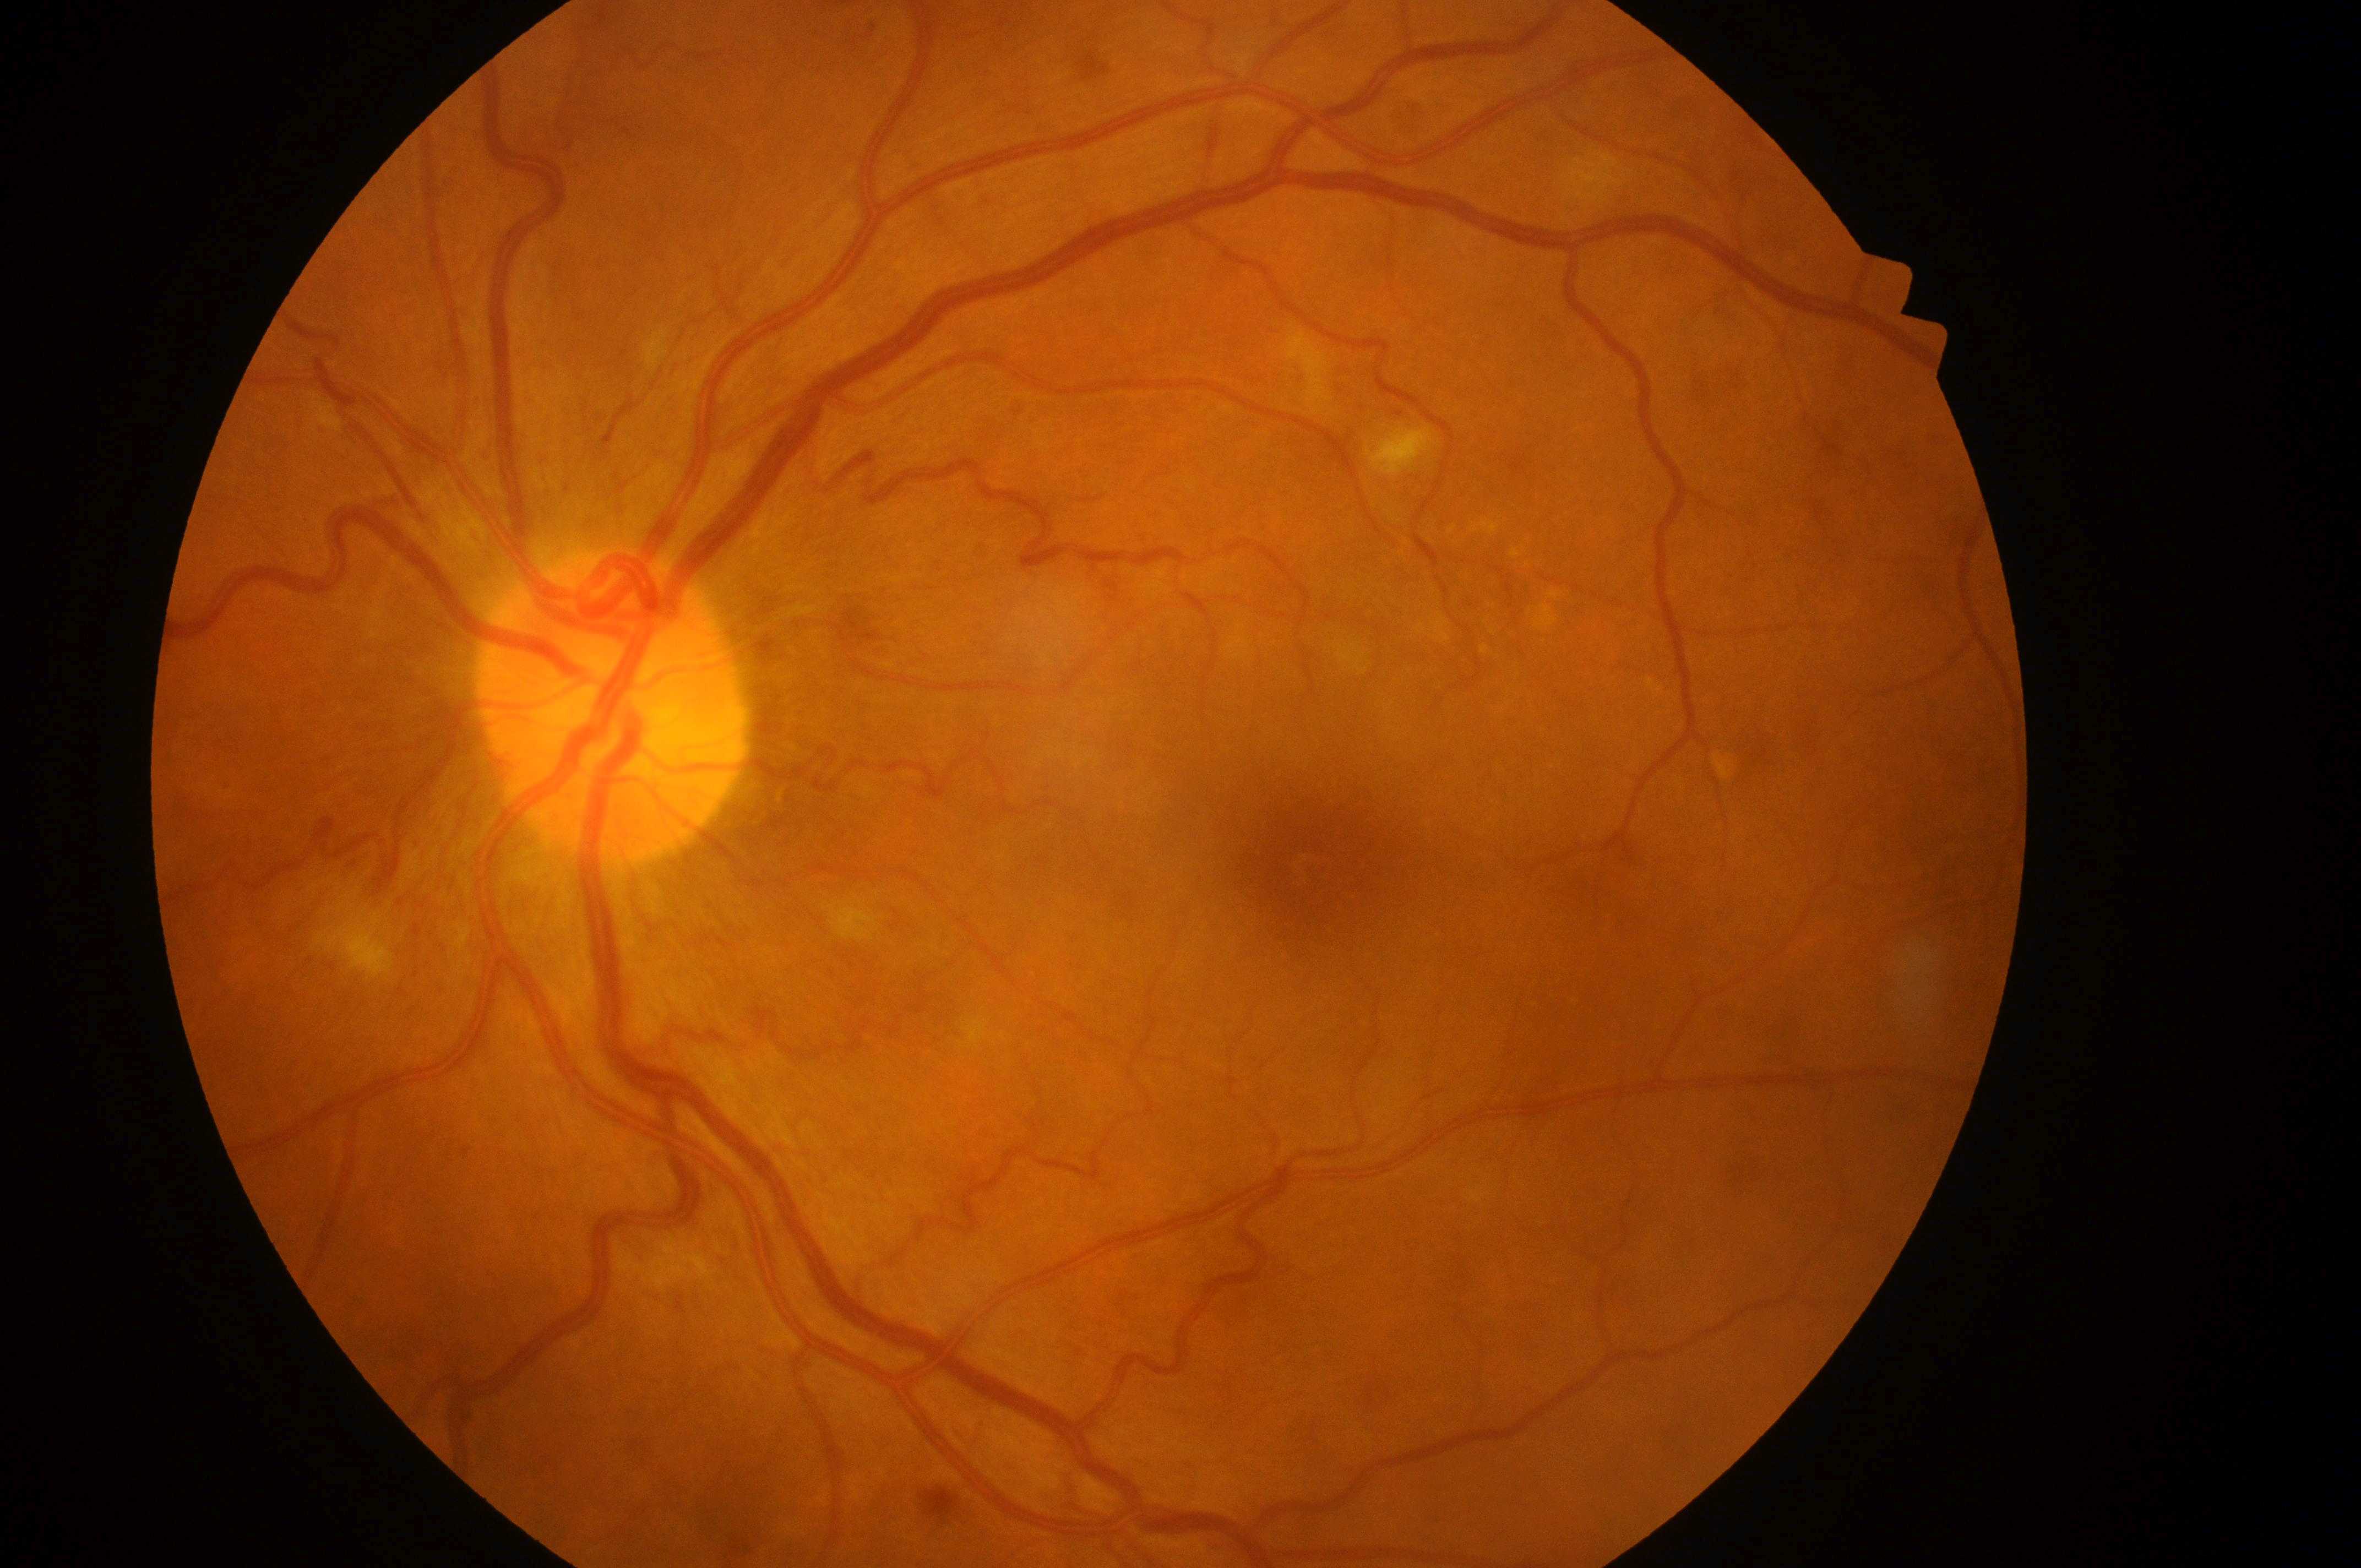
Fovea located at [1328, 872].
Eye: left.
Optic disc center located at [608, 726].
Macular edema is grade 0 (no risk).
The retinopathy is classified as non-proliferative diabetic retinopathy.
Retinopathy grade is moderate NPDR (2).